Posterior pole color fundus photograph: 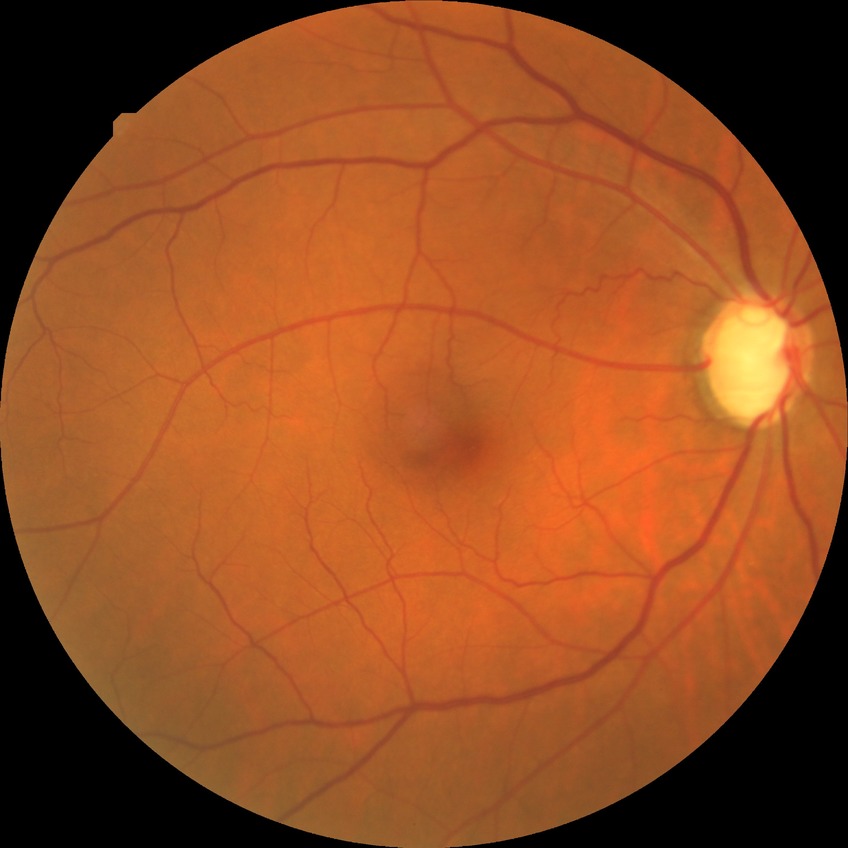

diabetic retinopathy (DR): simple diabetic retinopathy (SDR)